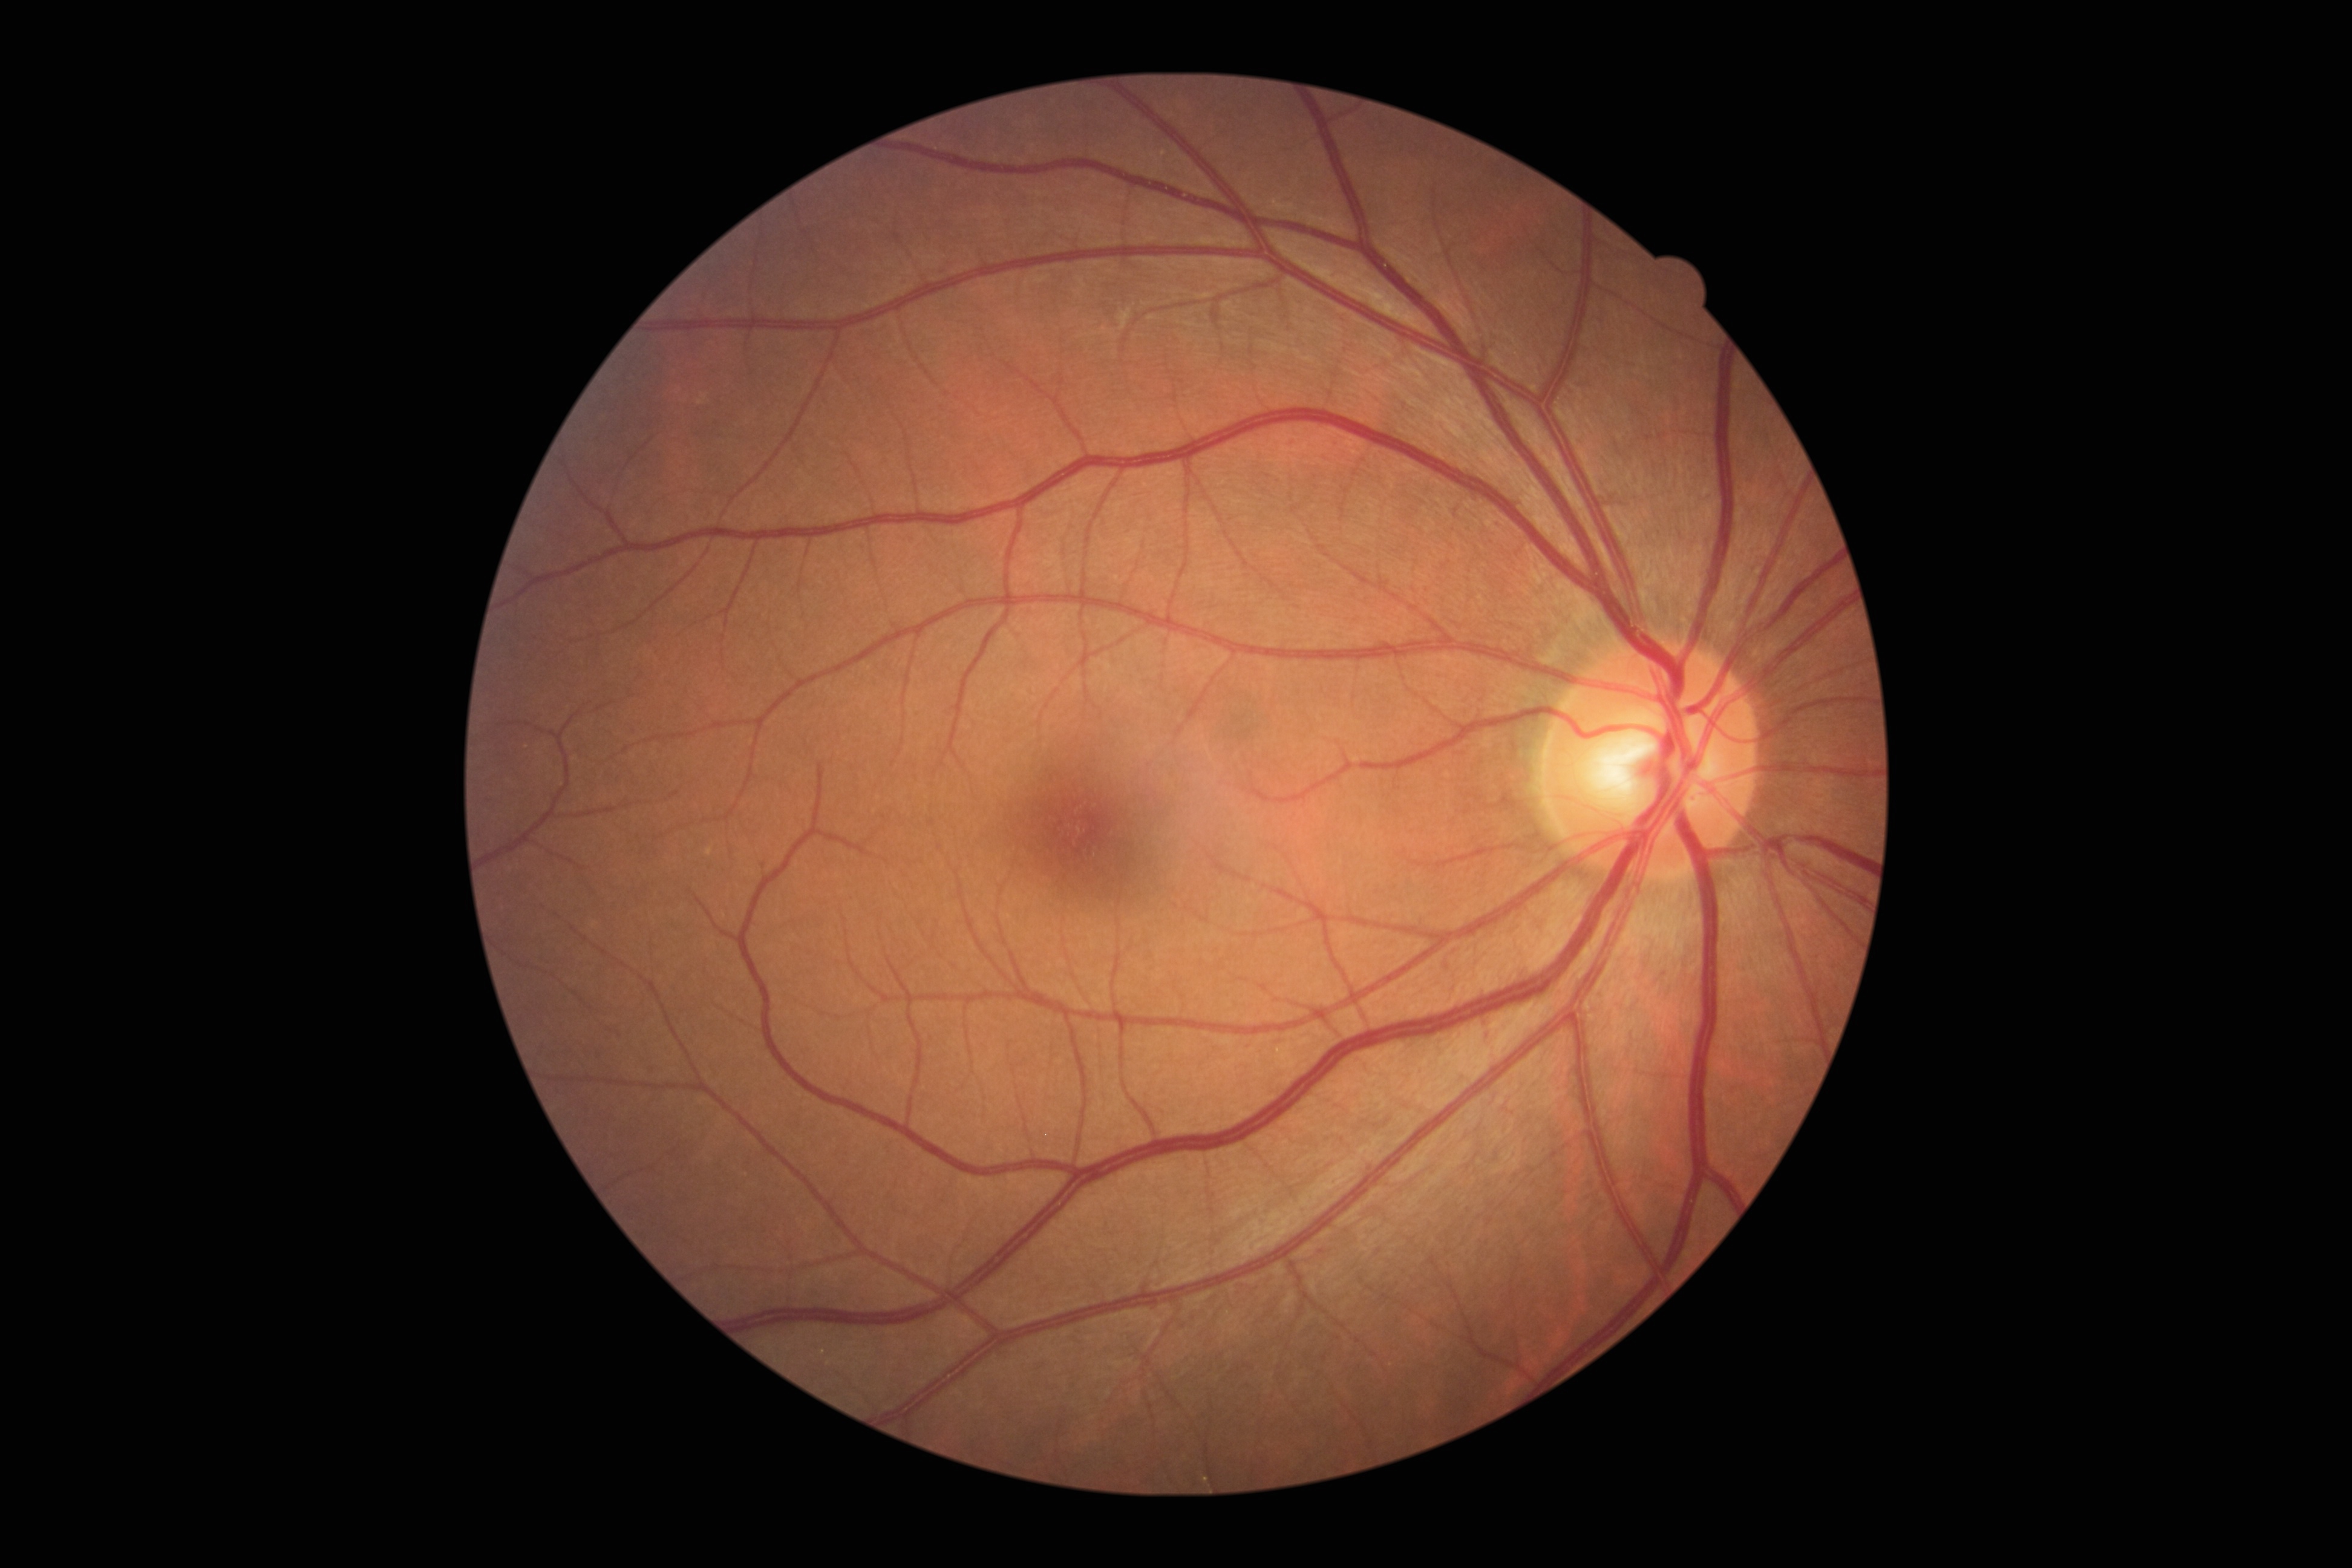

Diabetic retinopathy (DR) is 0/4 — no visible signs of diabetic retinopathy.
No apparent diabetic retinopathy.